Fundus photo; 45° FOV — 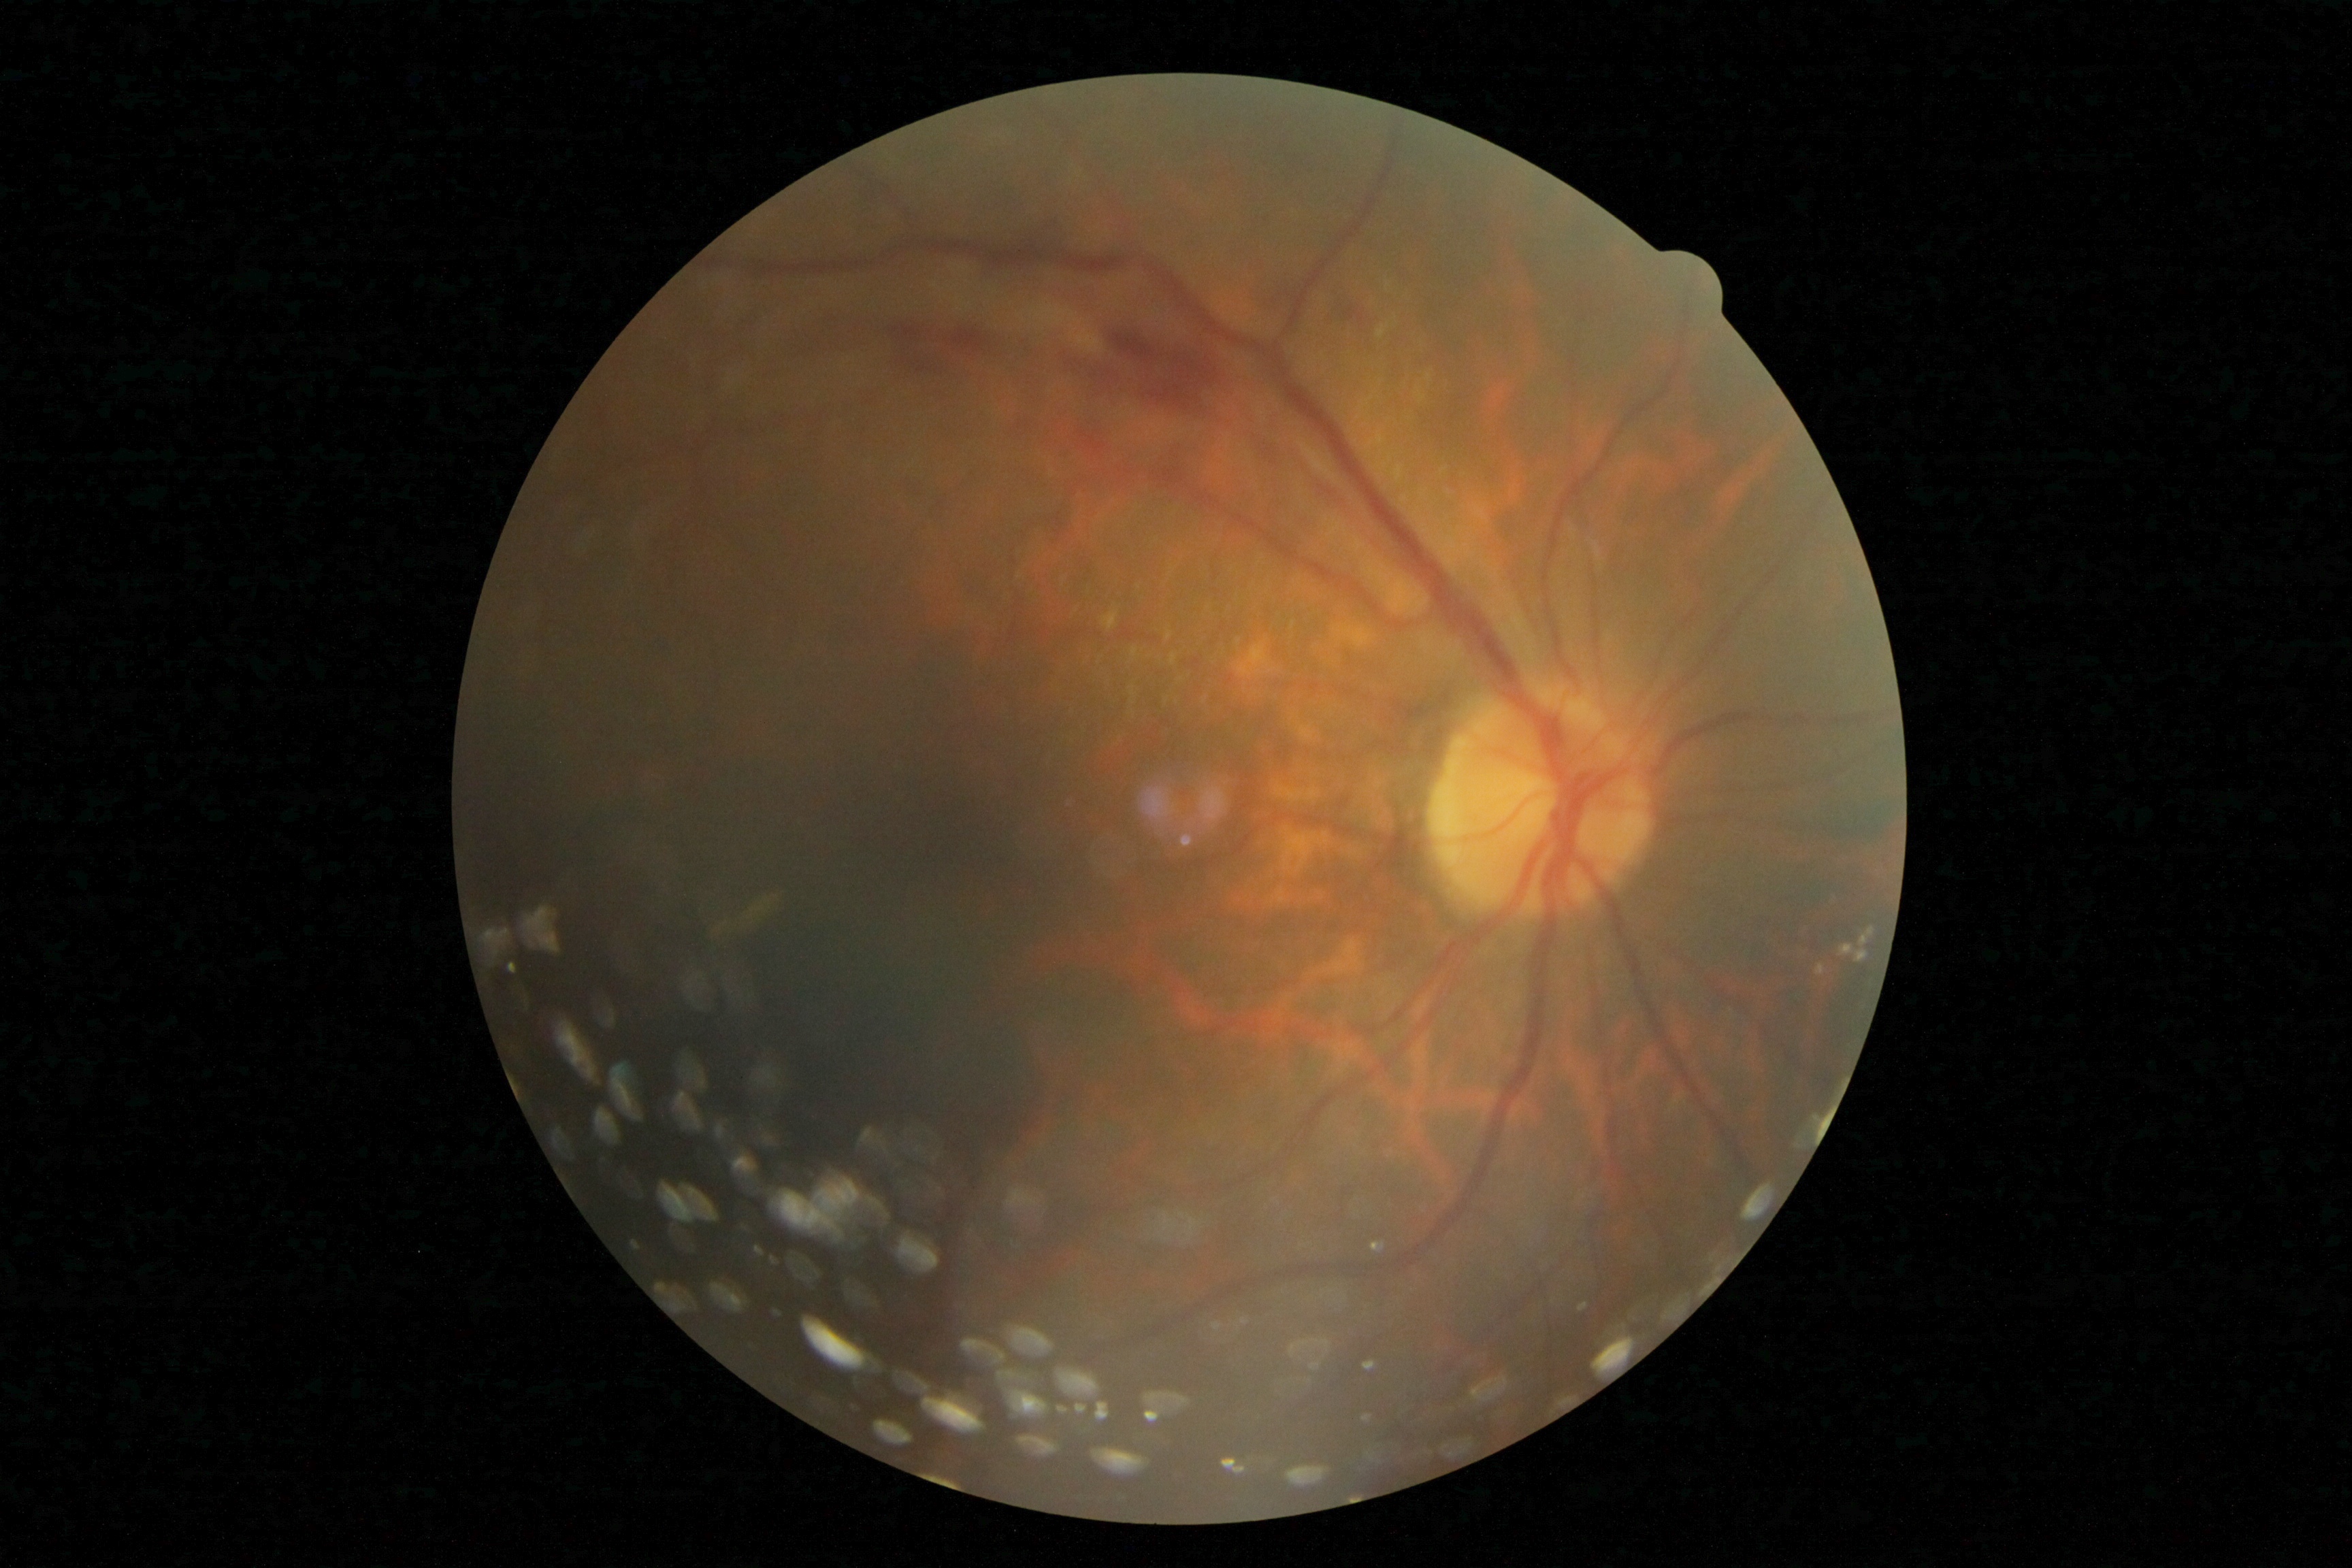 DR grade: 2 (moderate NPDR) — more than just microaneurysms but less than severe NPDR.
The retinopathy is classified as non-proliferative diabetic retinopathy.